Camera: Nidek AFC-330
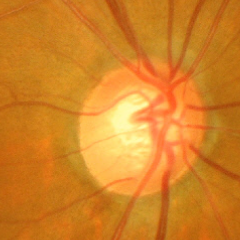
Glaucomatous optic neuropathy is present. Fundus appearance consistent with severe glaucomatous damage.